Acquired on the Phoenix ICON; pediatric wide-field fundus photograph:
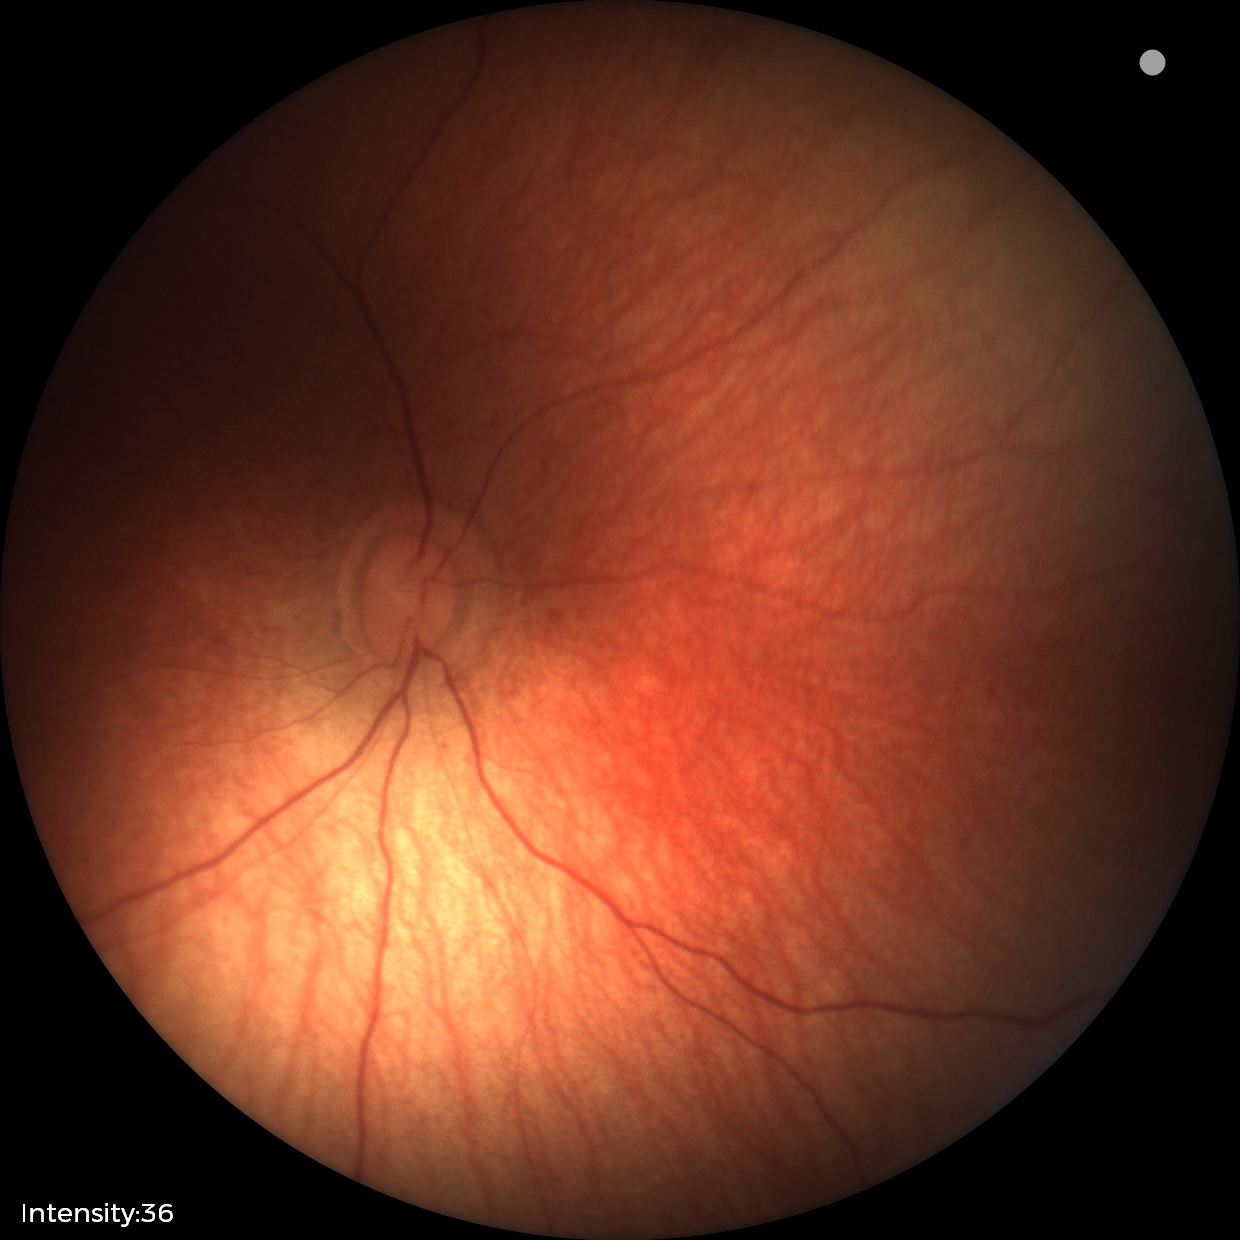 Examination with physiological retinal findings.